640 by 480 pixels. 130° field of view (Clarity RetCam 3). Pediatric wide-field fundus photograph:
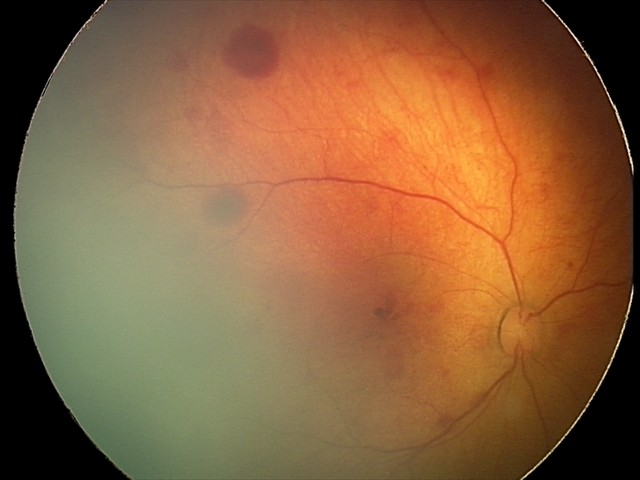 Q: What is the diagnosis from this examination?
A: retinal hemorrhages